Retinal fundus photograph. 50° FOV. 2228x1652px. Posterior pole field covering the optic disc and macula. Mydriatic (tropicamide and phenylephrine).
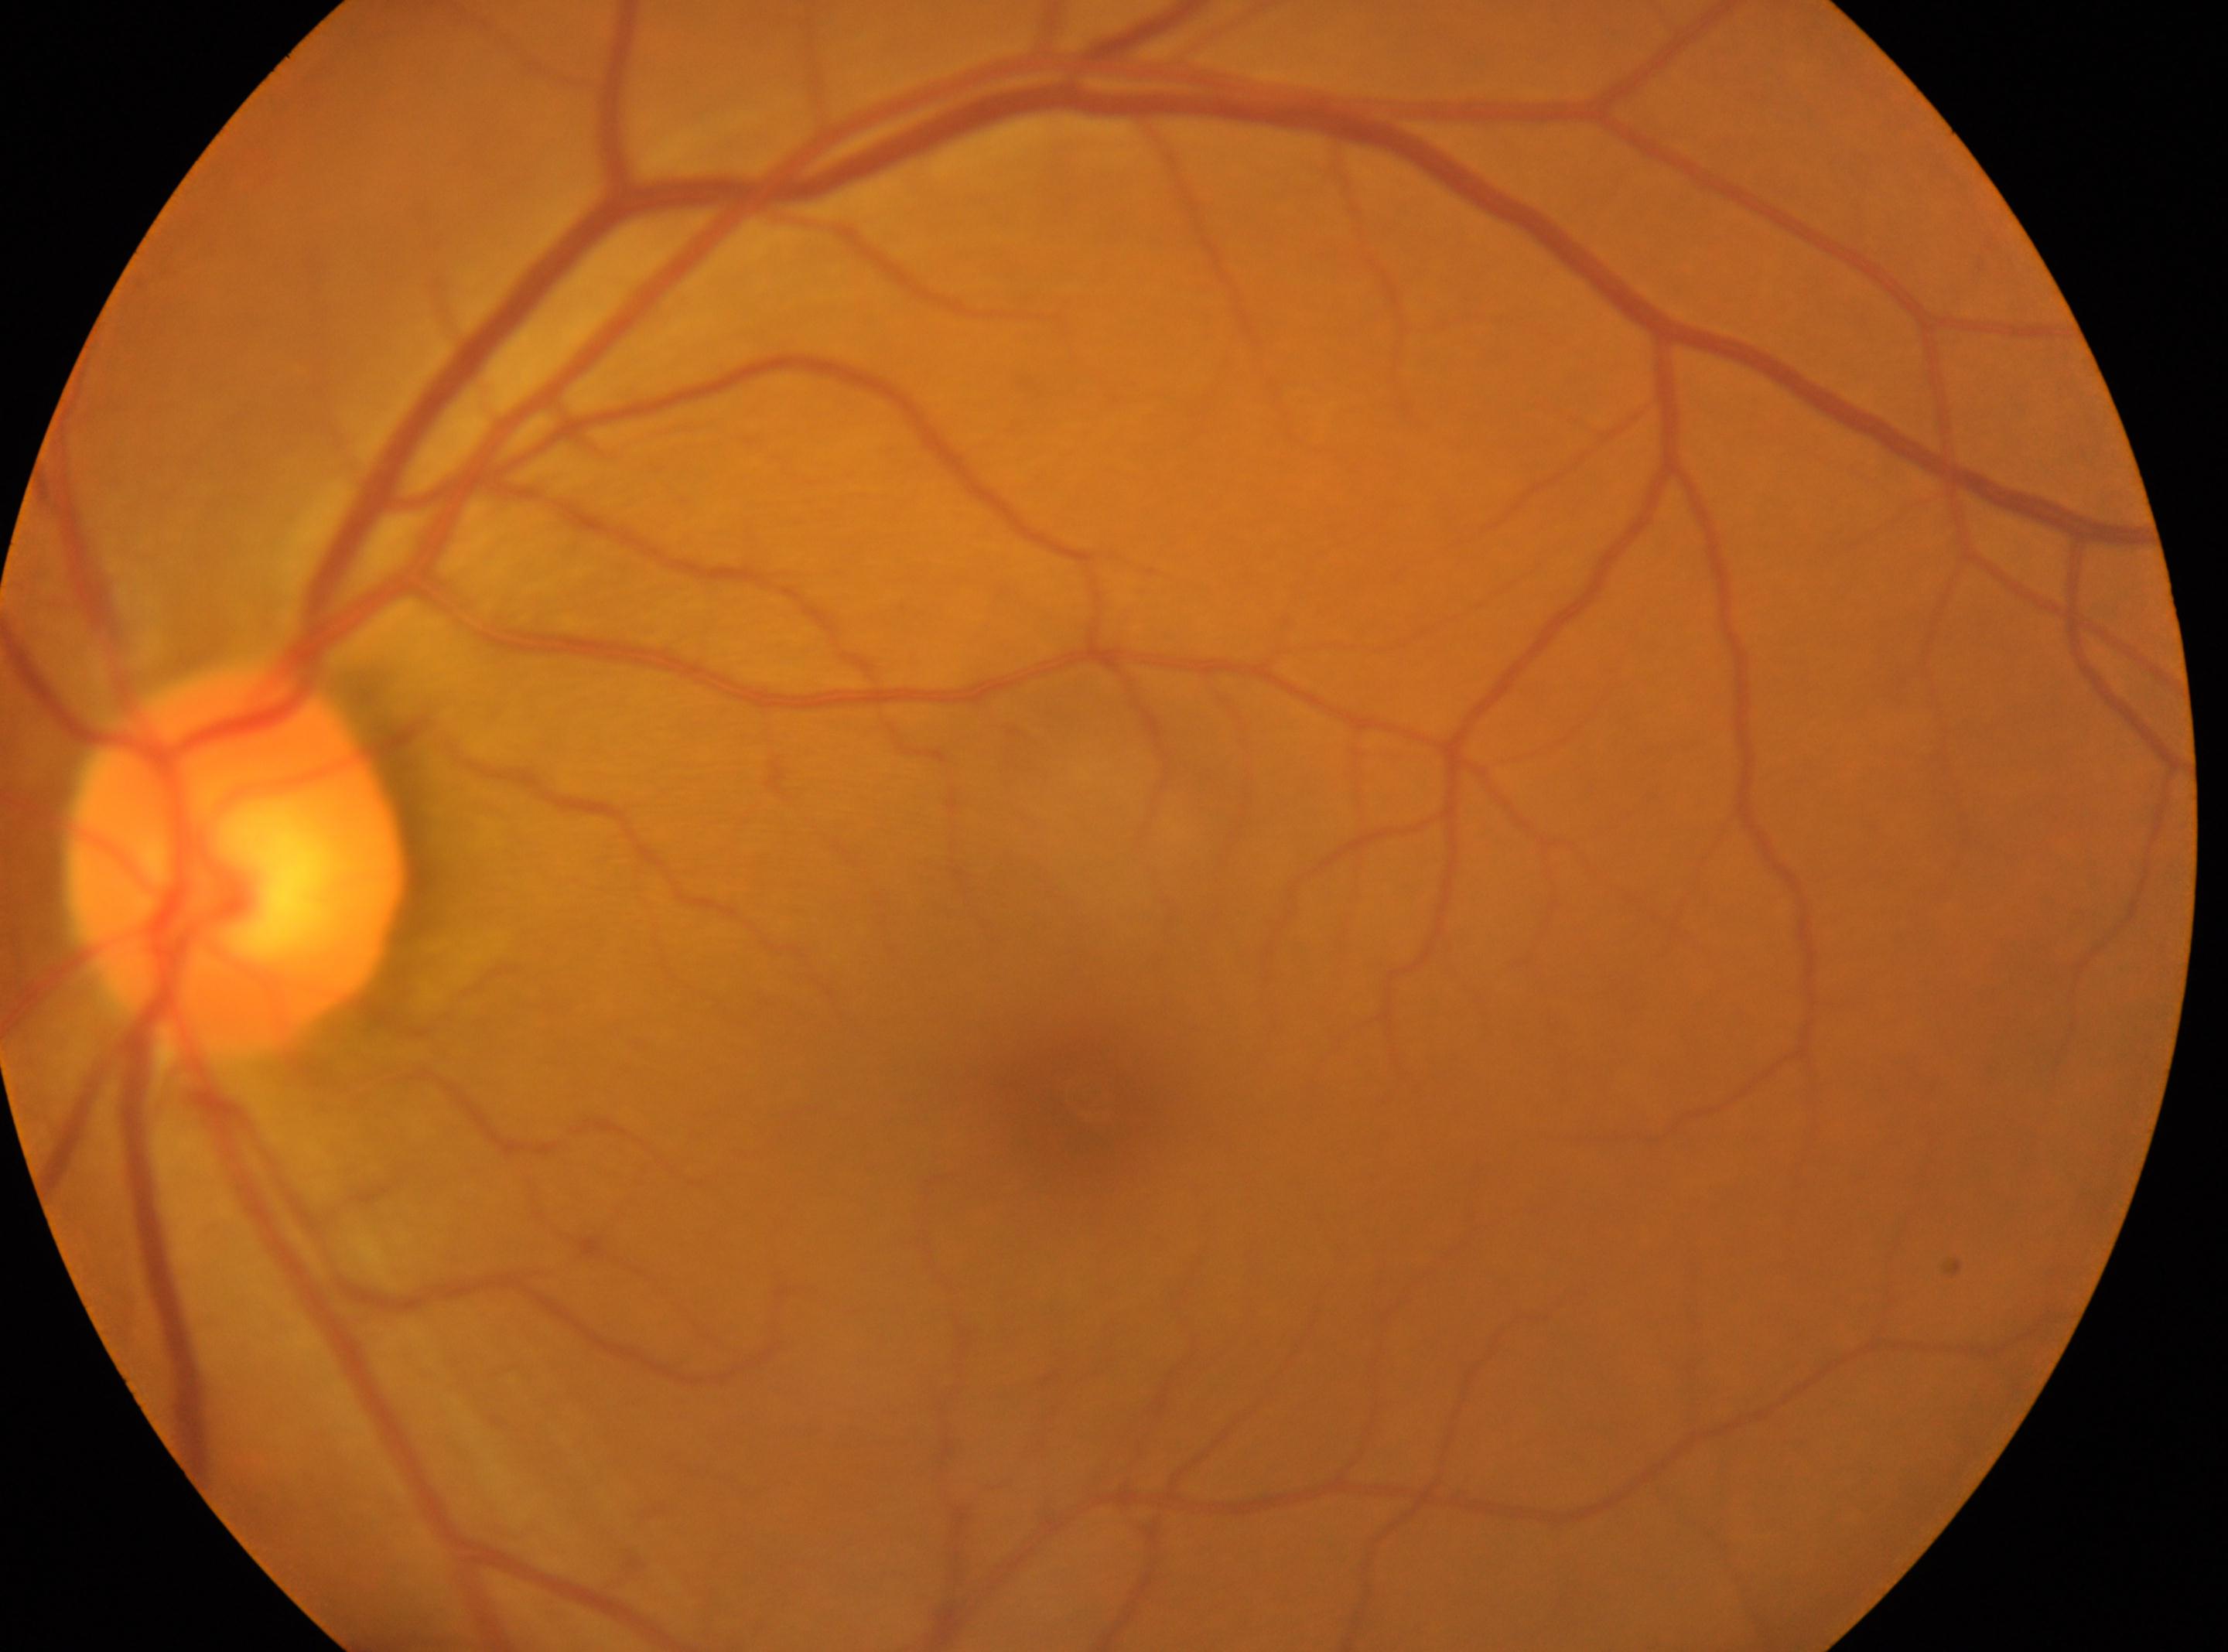
Diabetic retinopathy severity is 0. The macular center is at 1092, 1100. Imaged eye: oculus sinister. Optic disc: 234, 860. No apparent diabetic retinopathy.